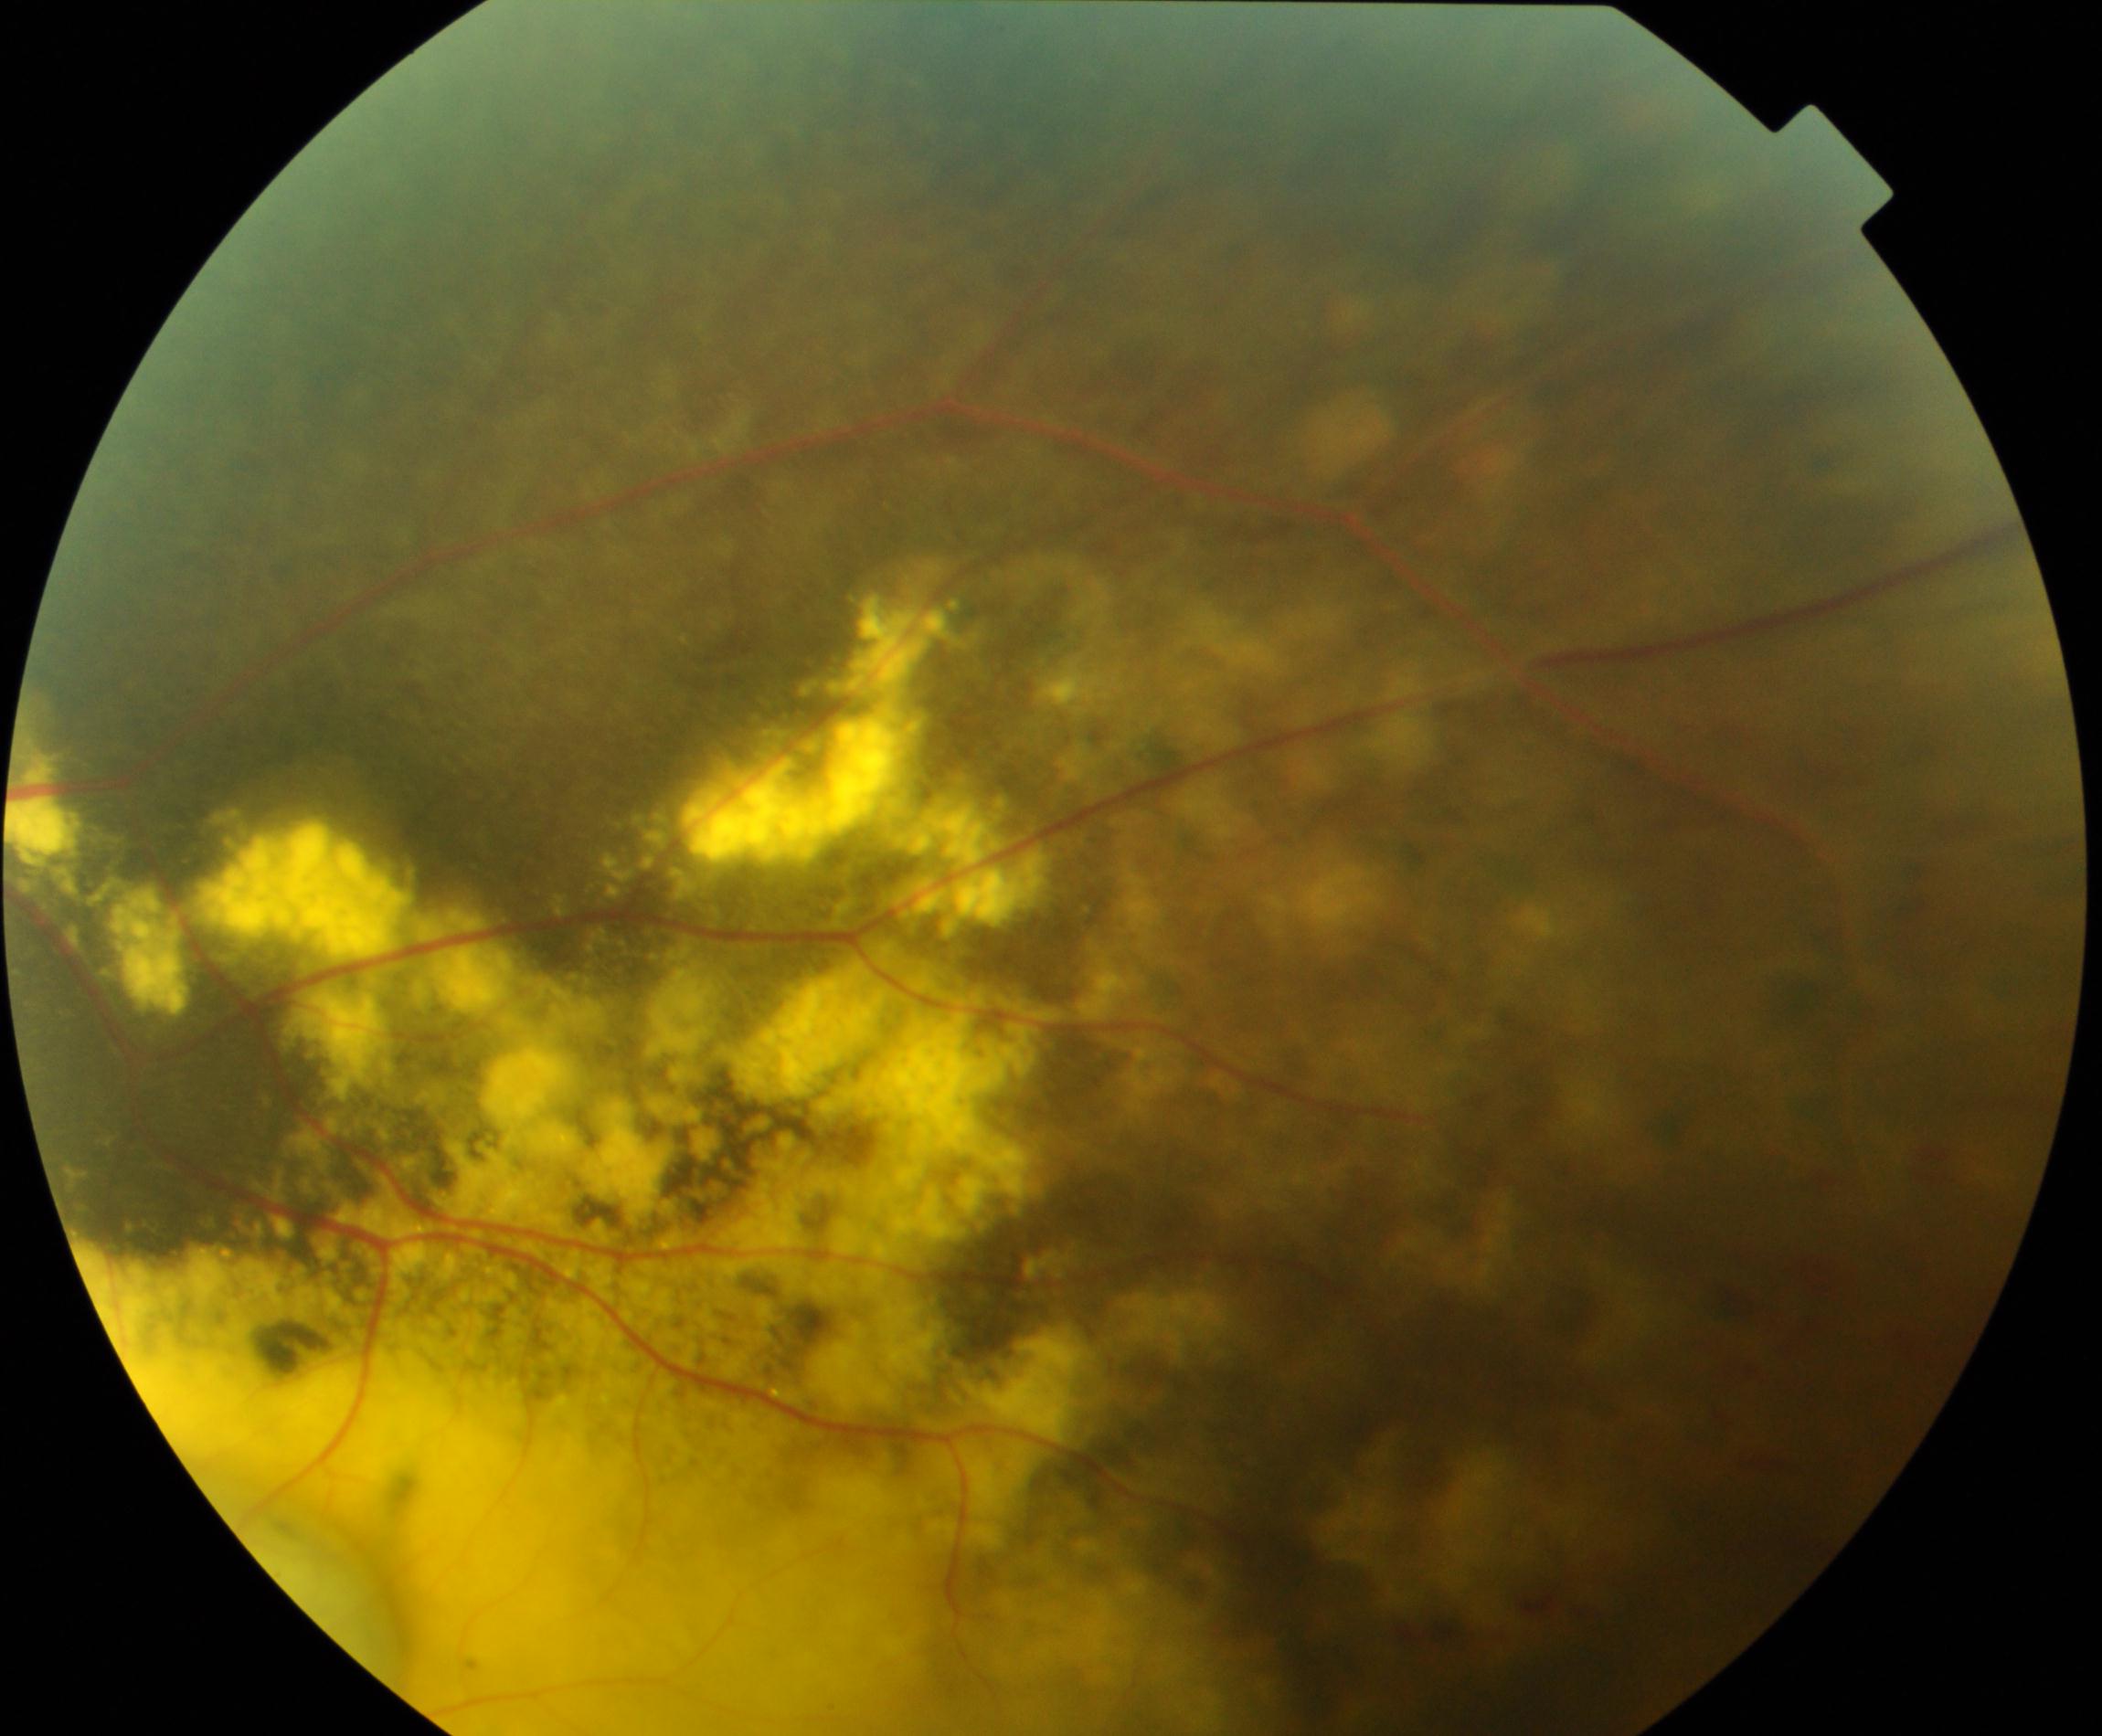

Diagnosis: massive hard exudates. Typically showing waxy yellow lesions with distinct margins arranged in large clumps, usually caused by vascular abnormalities.